Portable fundus camera image:
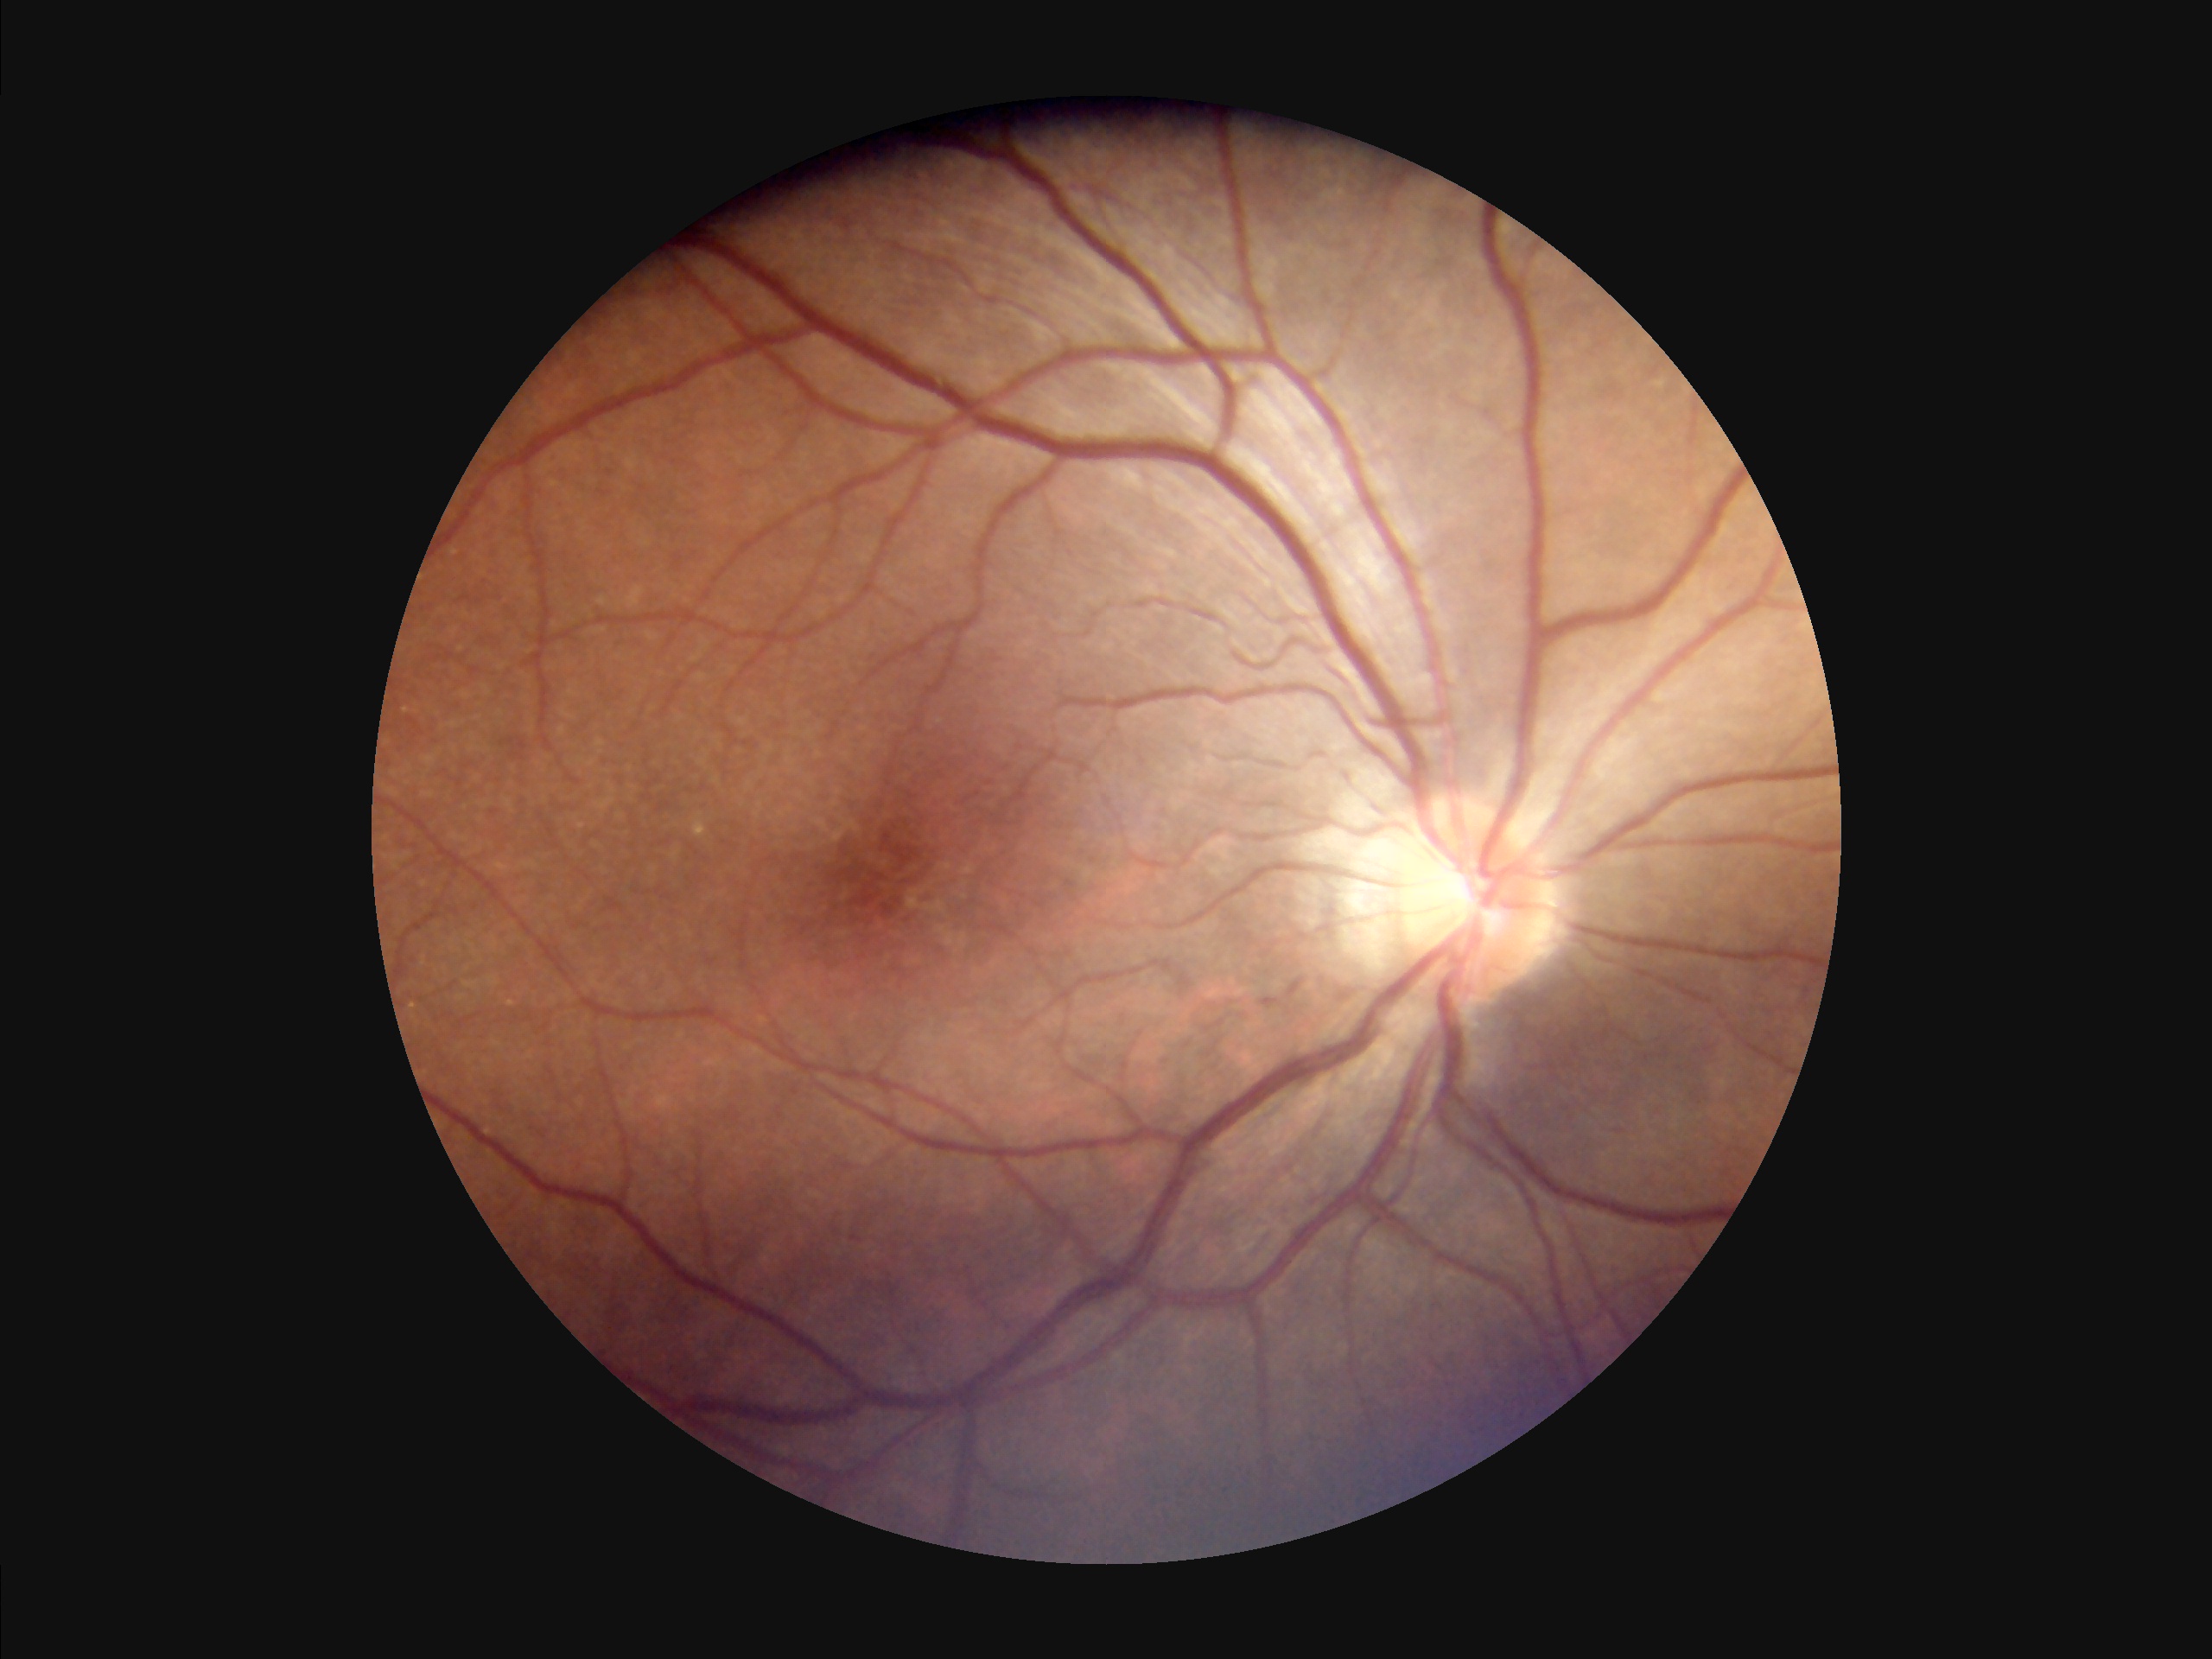 Quality grading: focus: sharp | illumination/color: even | overall: acceptable | contrast: adequate.